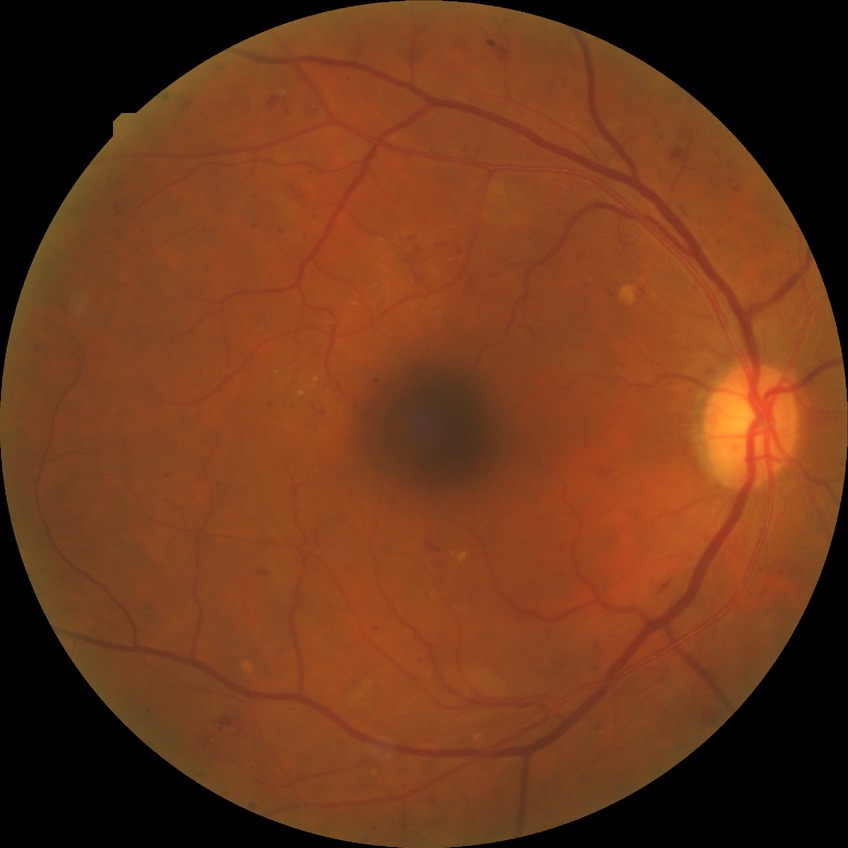
Modified Davis grade is PPDR.